Color fundus photograph.
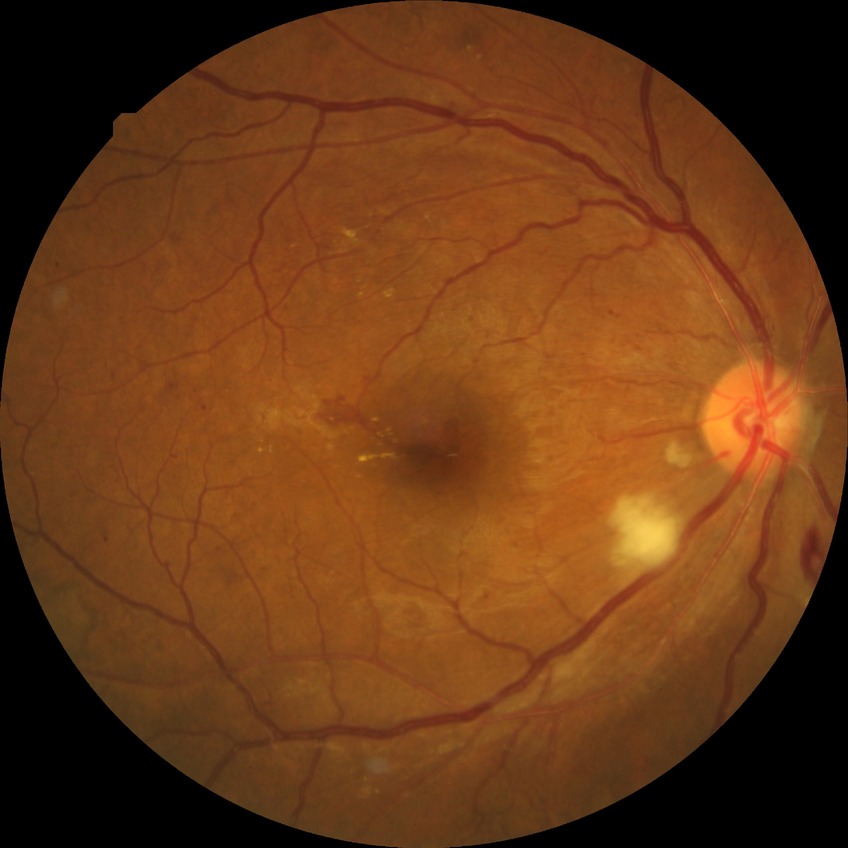

Diabetic retinopathy (DR): PDR (proliferative diabetic retinopathy).